CFP — 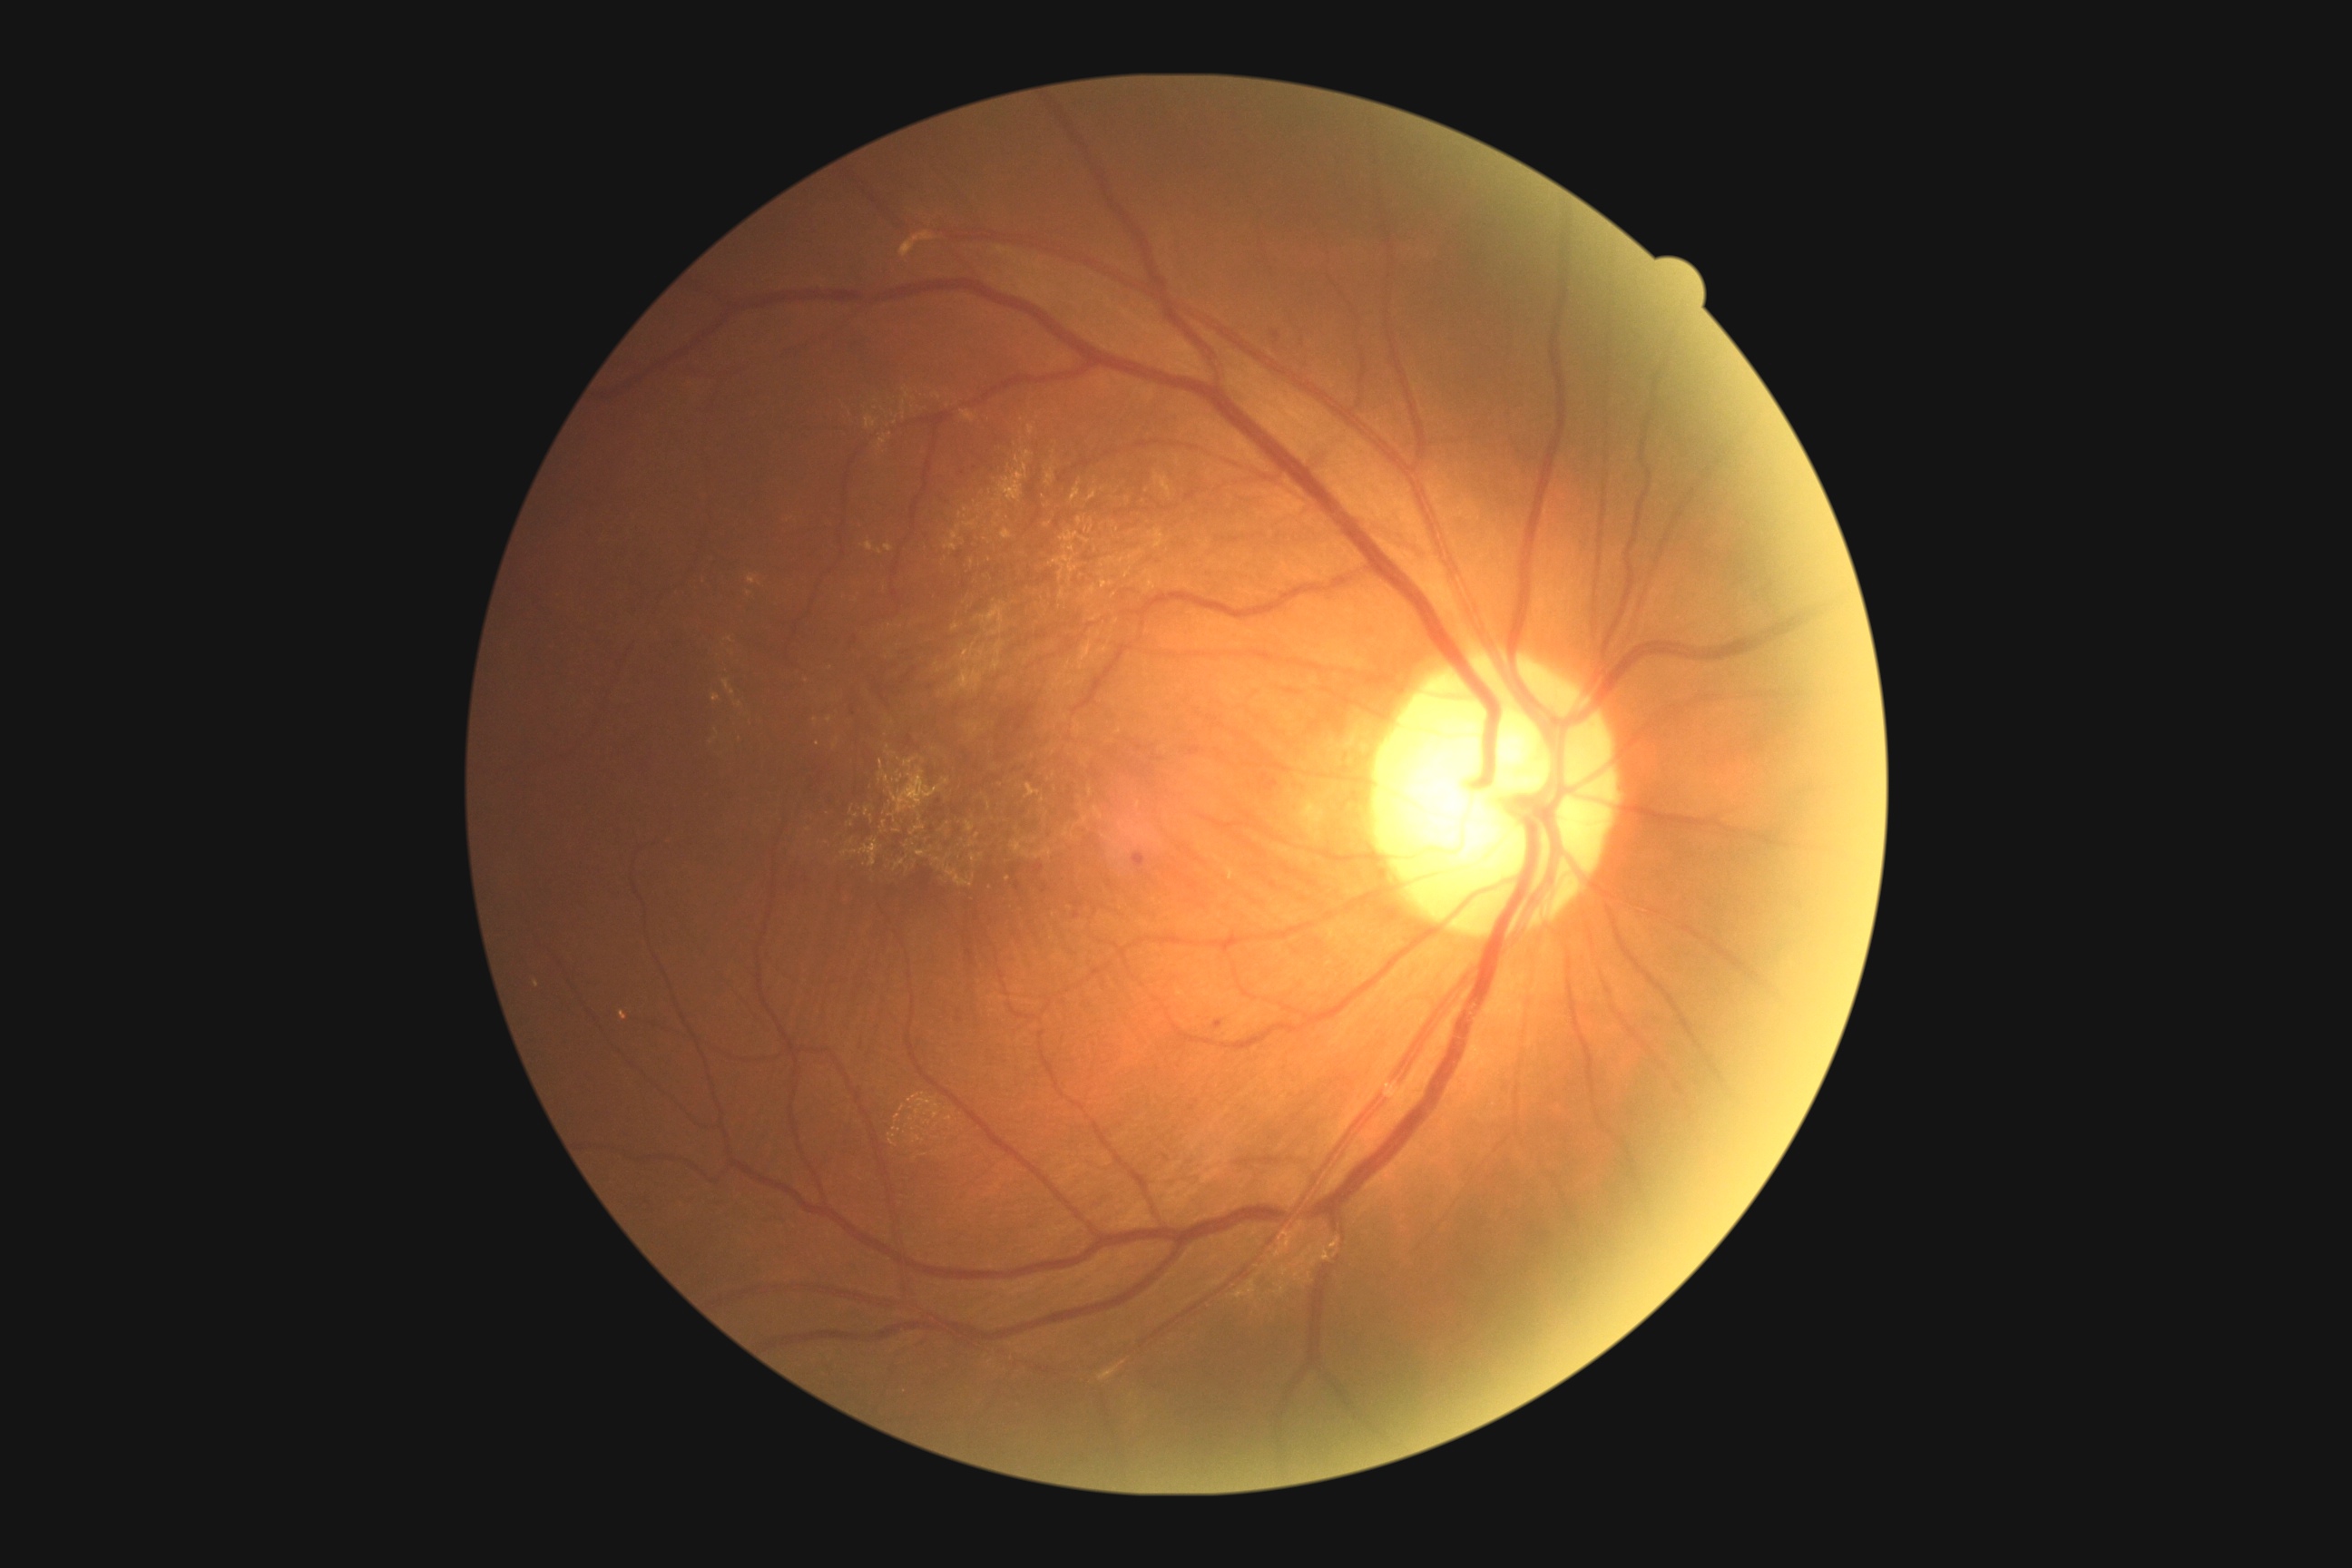 Diabetic retinopathy (DR) is grade 1 (mild NPDR)
hard exudates (EXs): not present
soft exudates (SEs): not present
microaneurysms (MAs): bbox(1035, 865, 1044, 874)
Additional small MAs near <pt>1045,891</pt>; <pt>975,469</pt>; <pt>963,474</pt>; <pt>1167,1158</pt>; <pt>1076,915</pt>; <pt>1018,886</pt>
hemorrhages (HEs): bbox(1271, 333, 1280, 340); bbox(1213, 1021, 1224, 1030); bbox(1133, 854, 1146, 867)